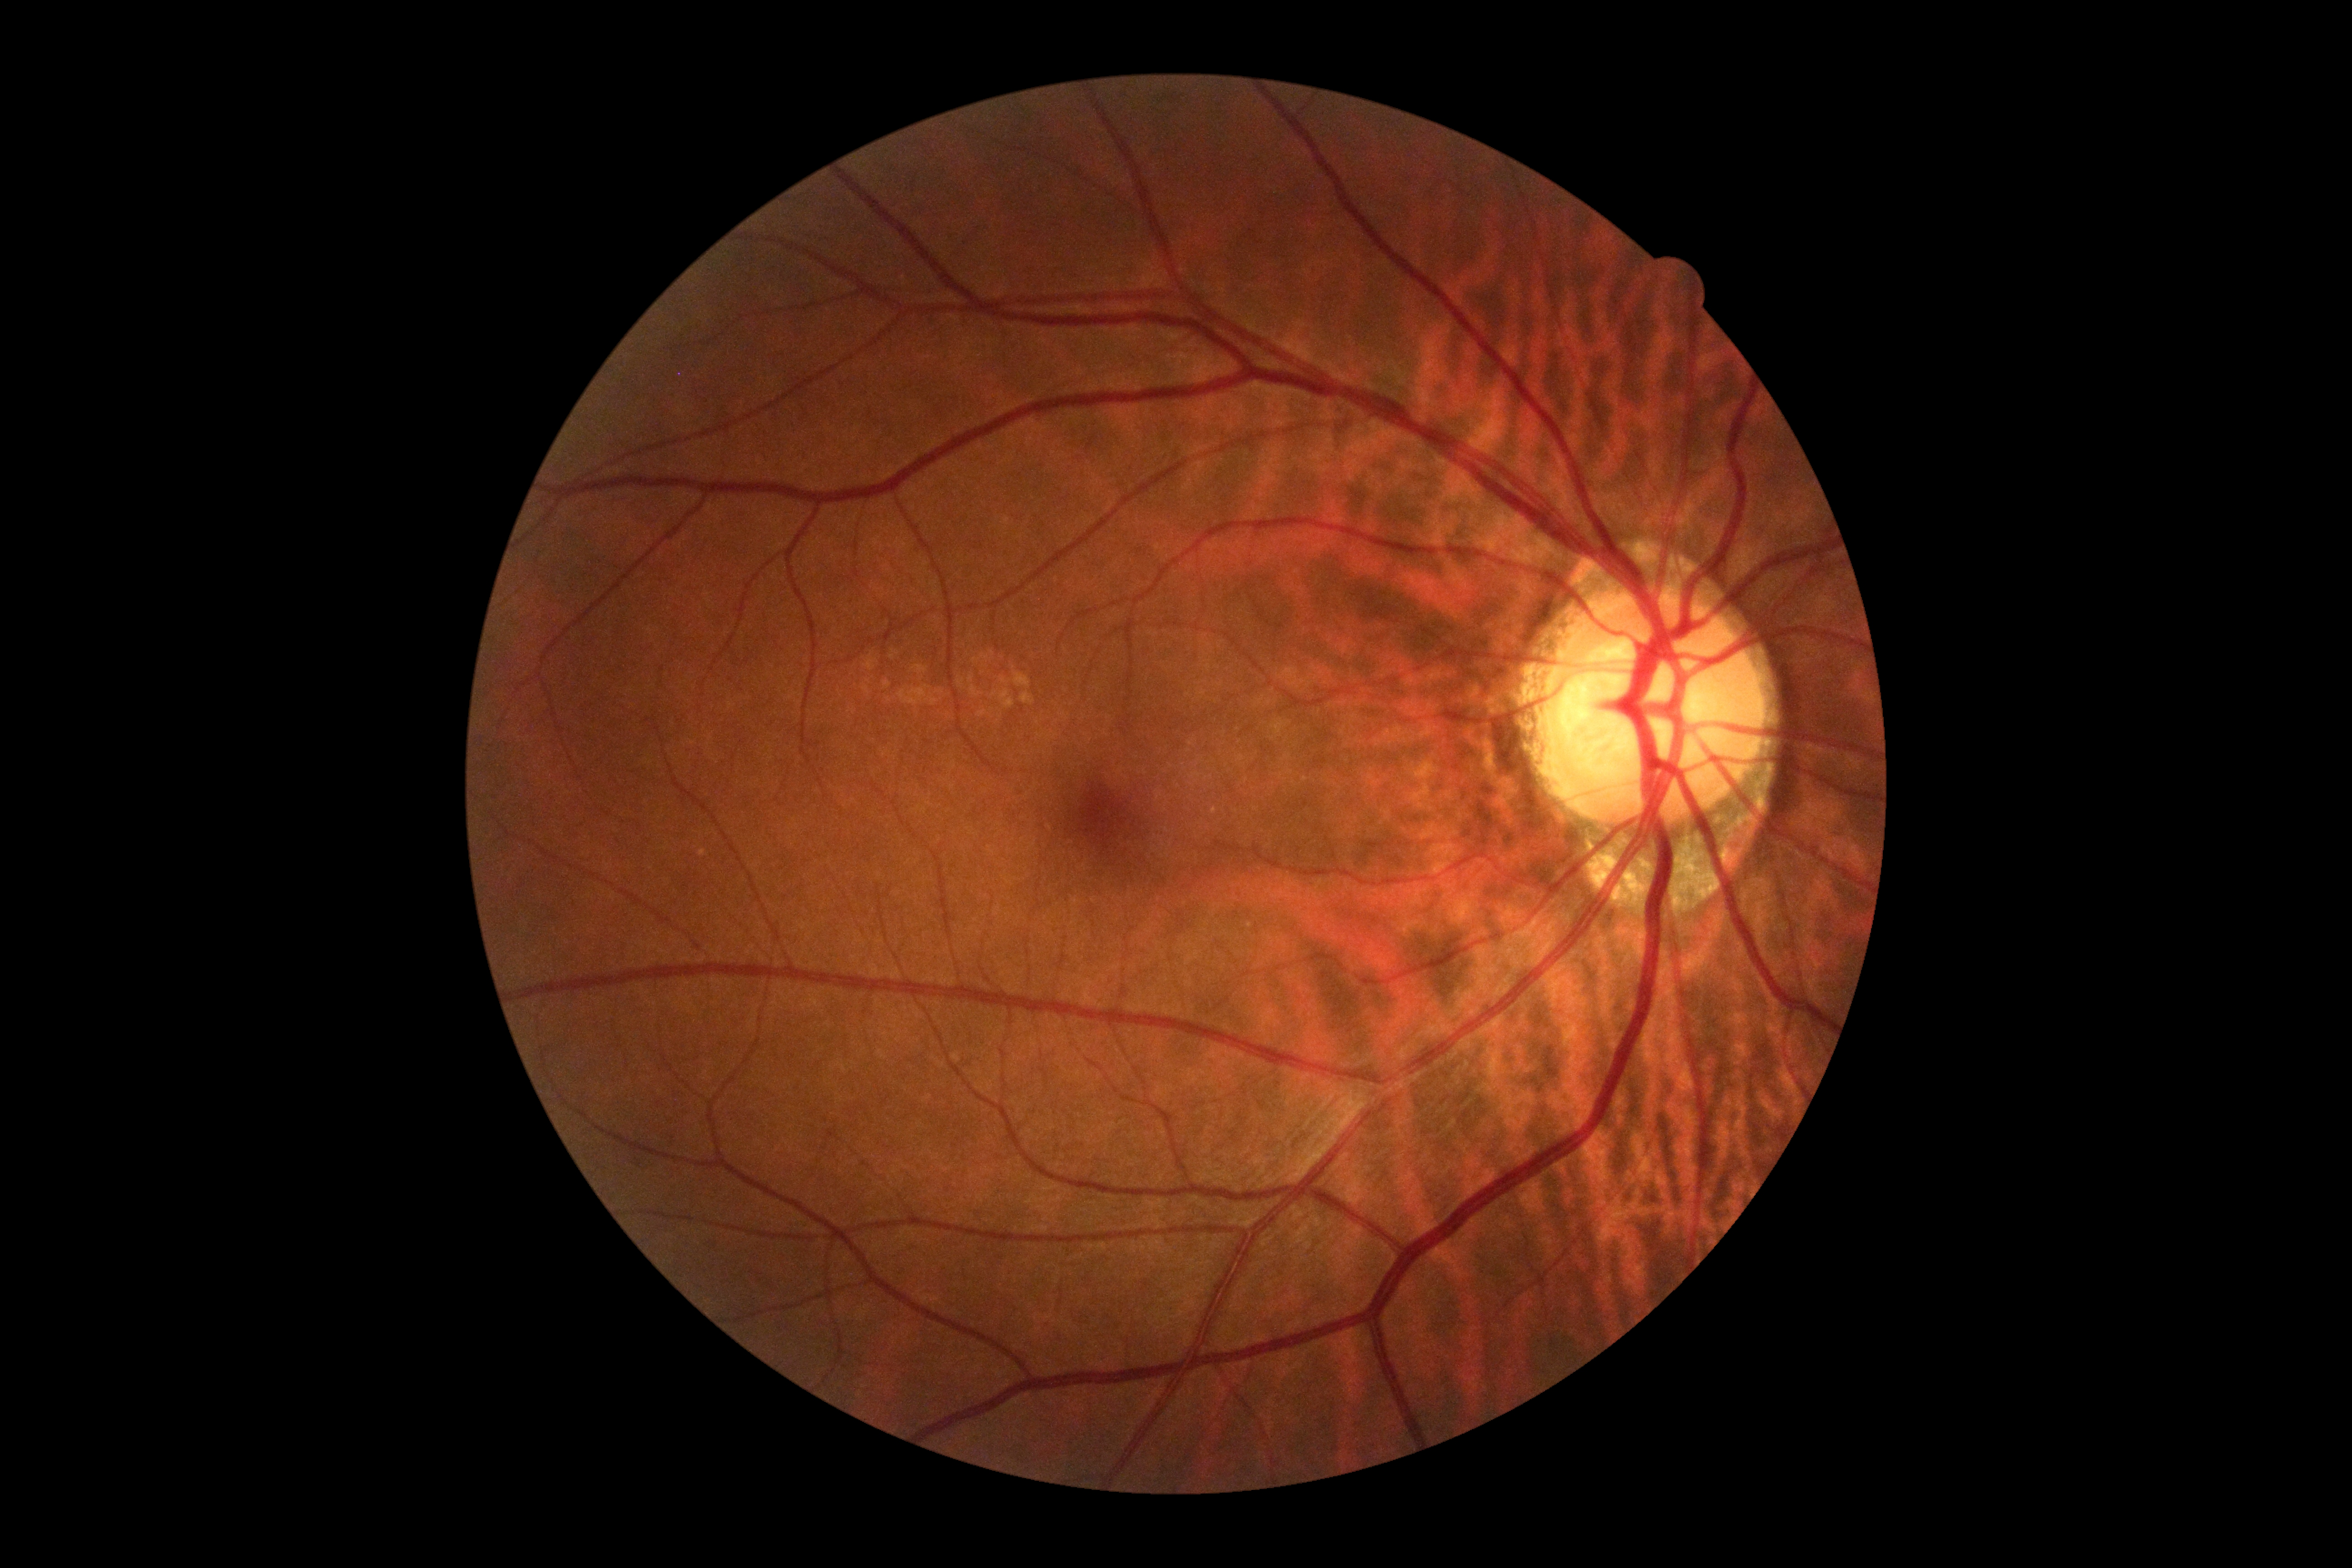

Diabetic retinopathy (DR): grade 0.